Modified Davis classification.
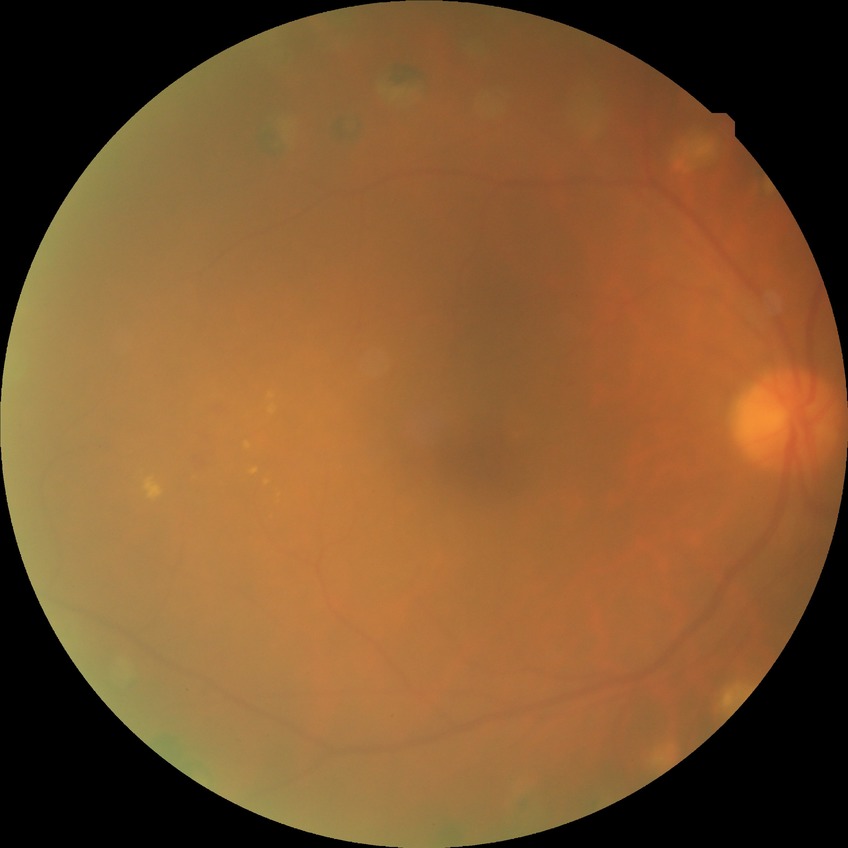 diabetic retinopathy (DR)=PDR (proliferative diabetic retinopathy).